Captured on a Remidio Fundus on Phone (FOP) camera — 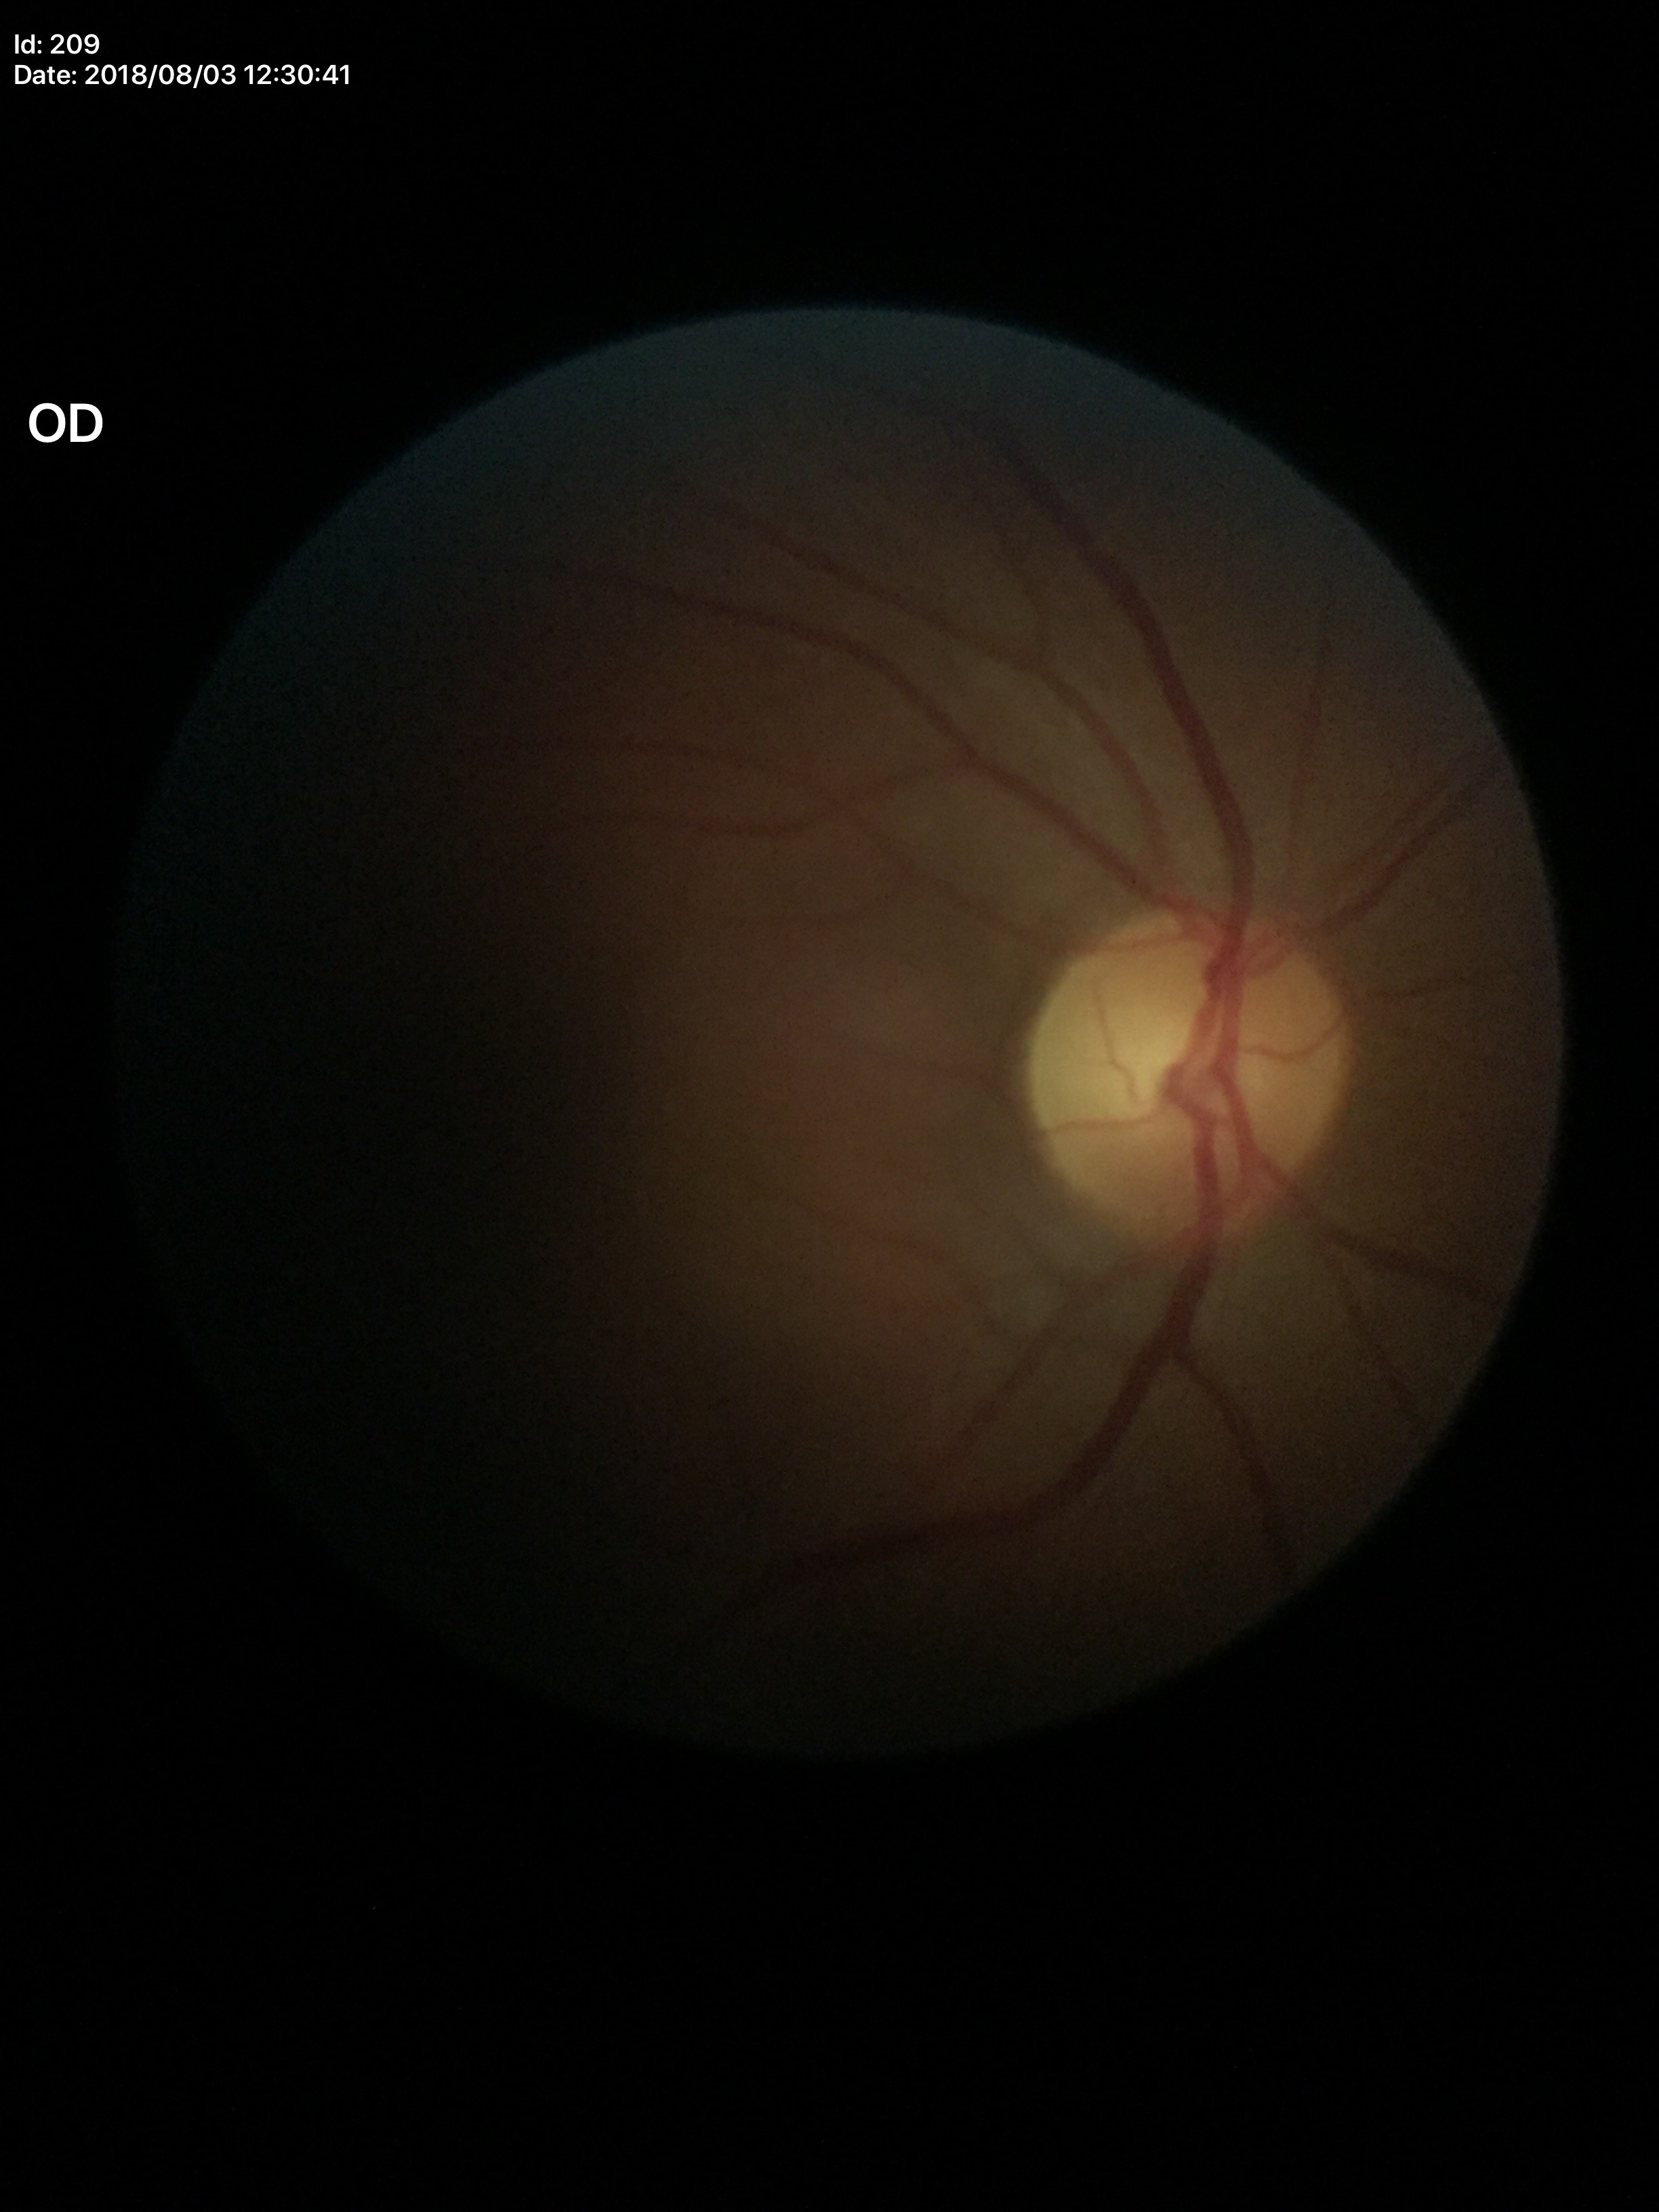 No evidence of glaucoma. Vertical CDR of 0.48.